Retinal fundus photograph, no pharmacologic dilation: 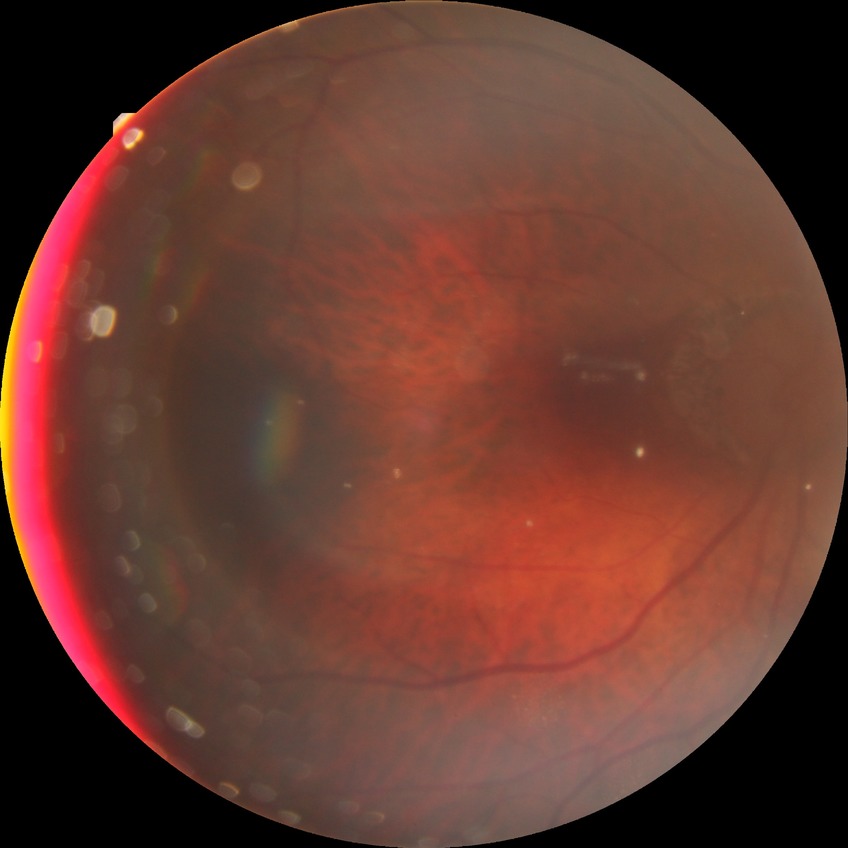 Davis stage: NDR.
No diabetic retinal disease findings.